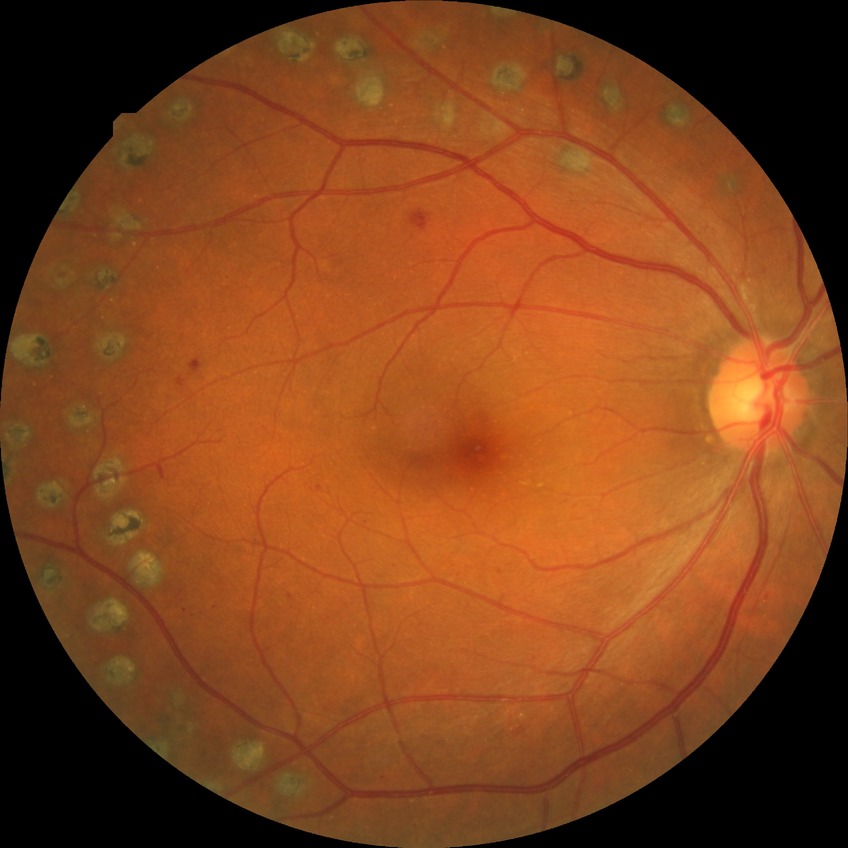

Modified Davis classification: proliferative diabetic retinopathy.